1932 x 1916 pixels.
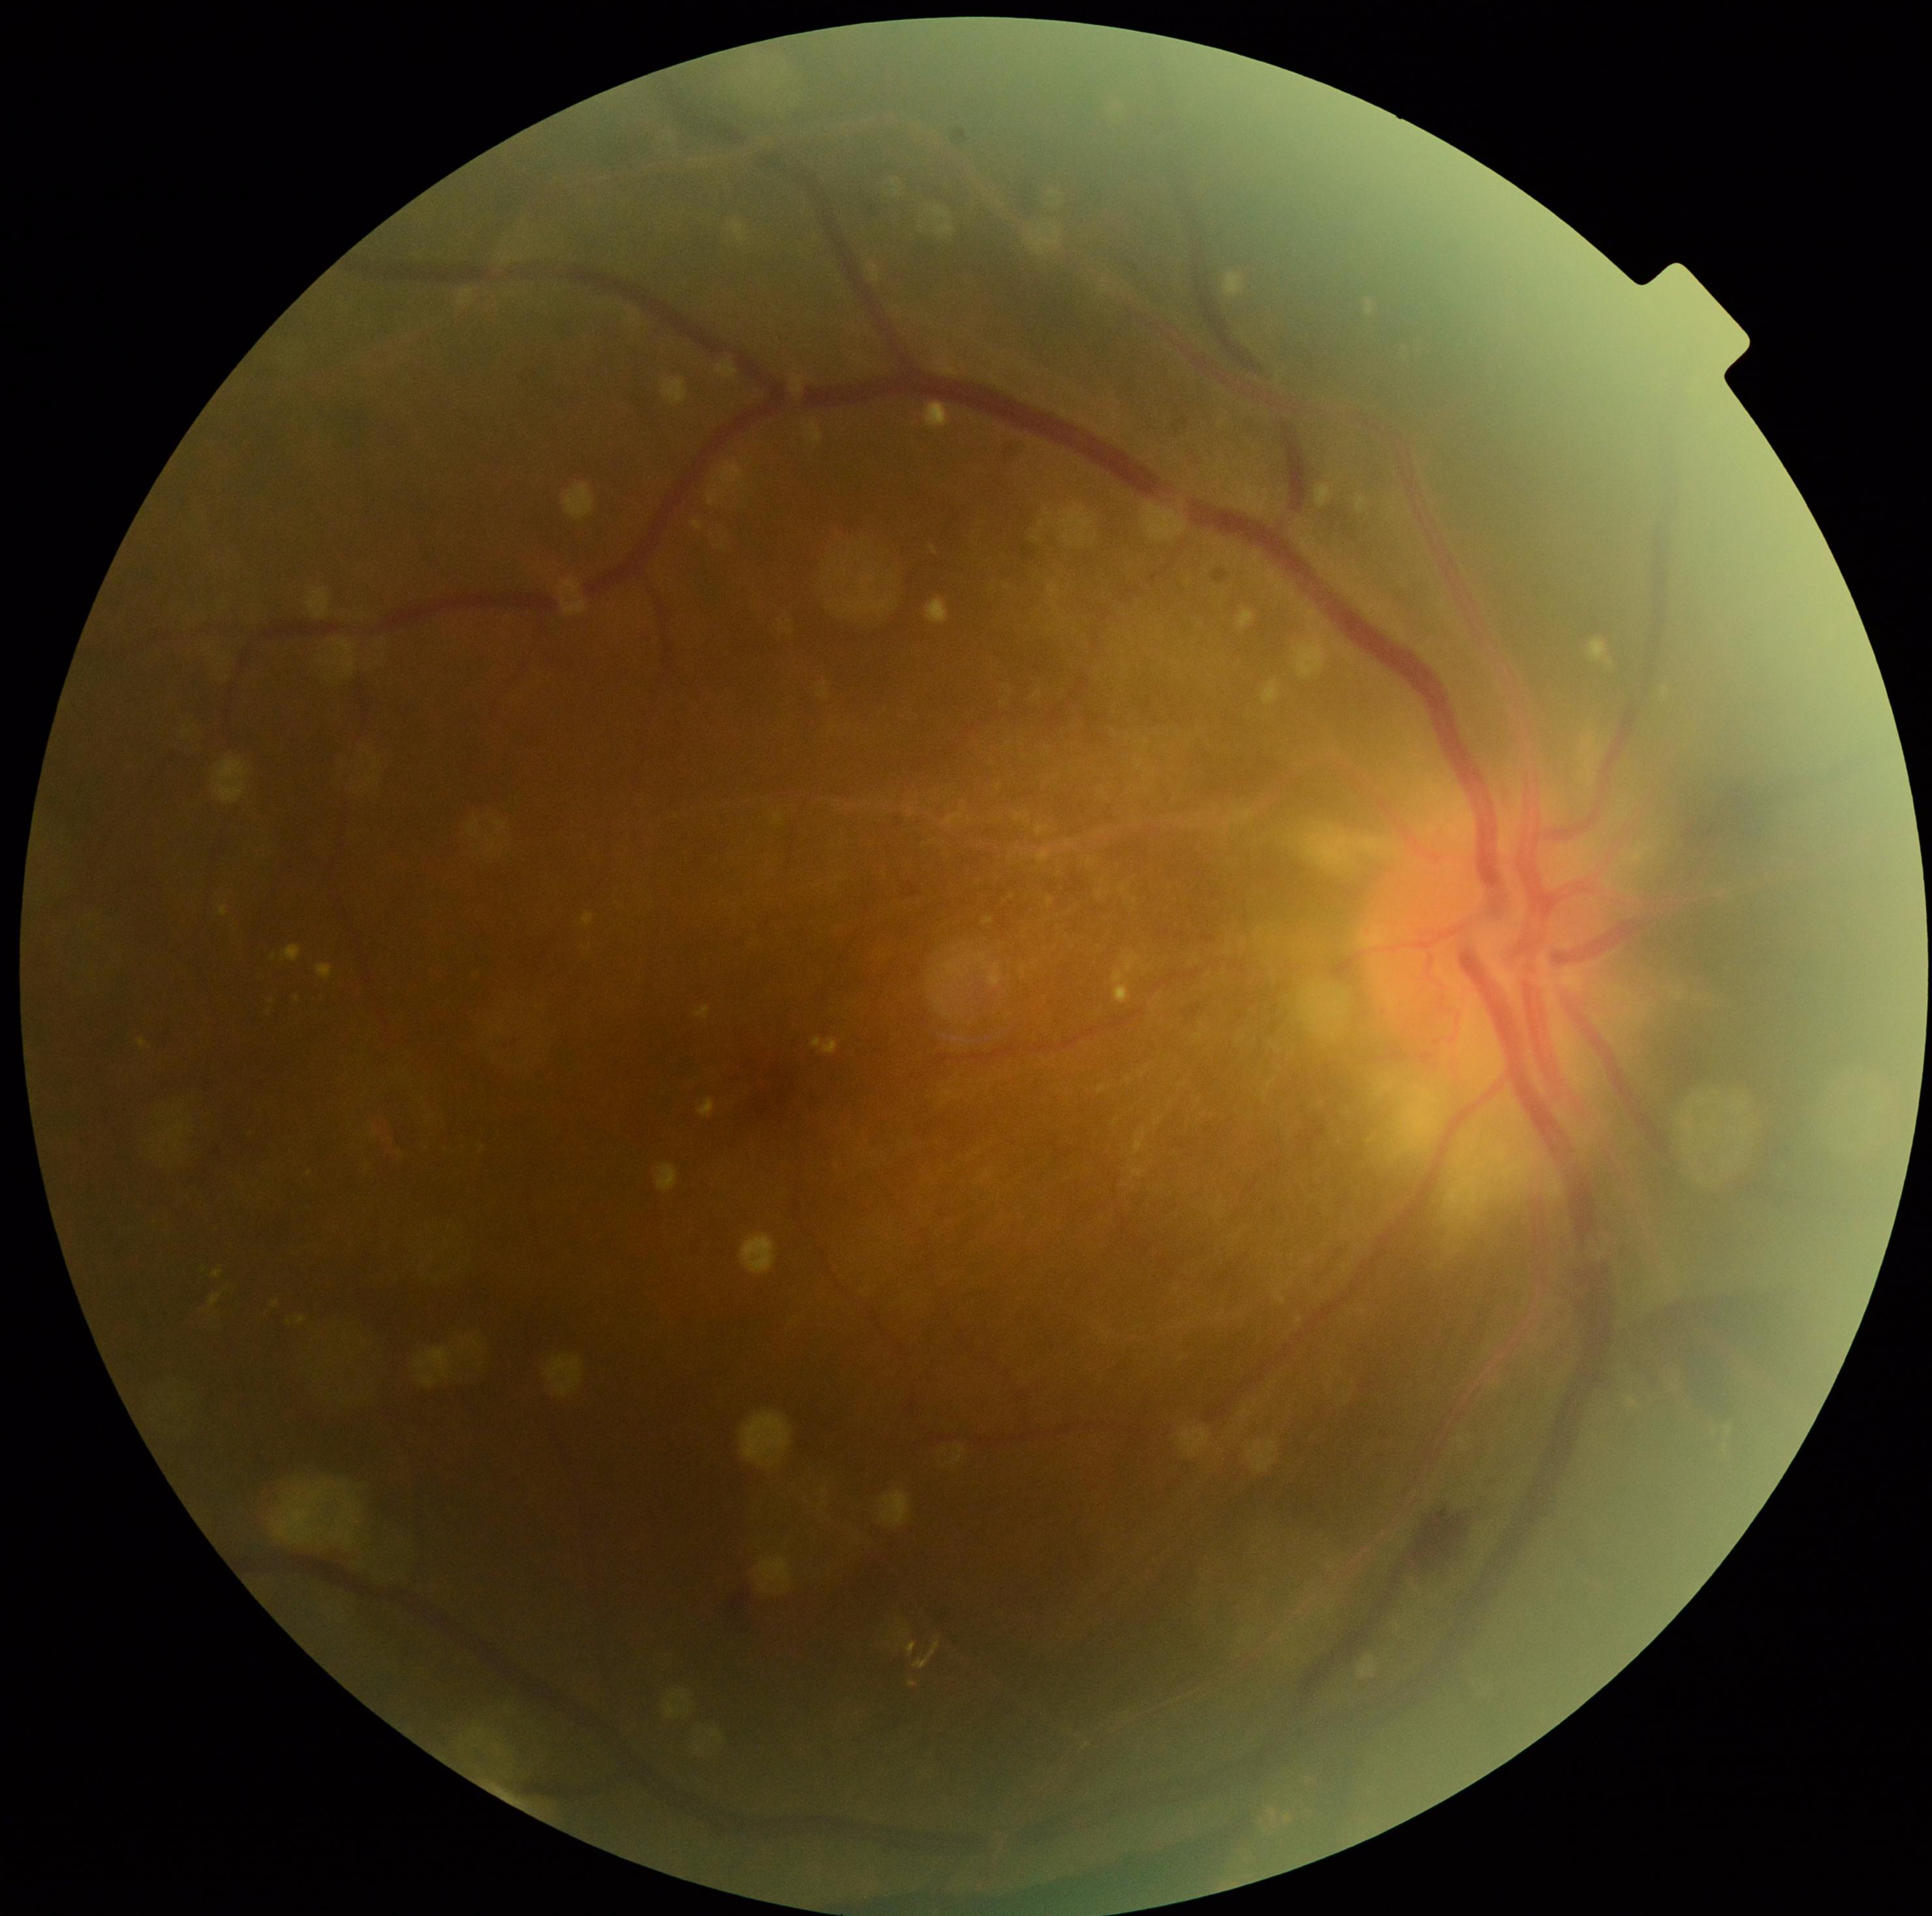

DR: PDR (grade 4).